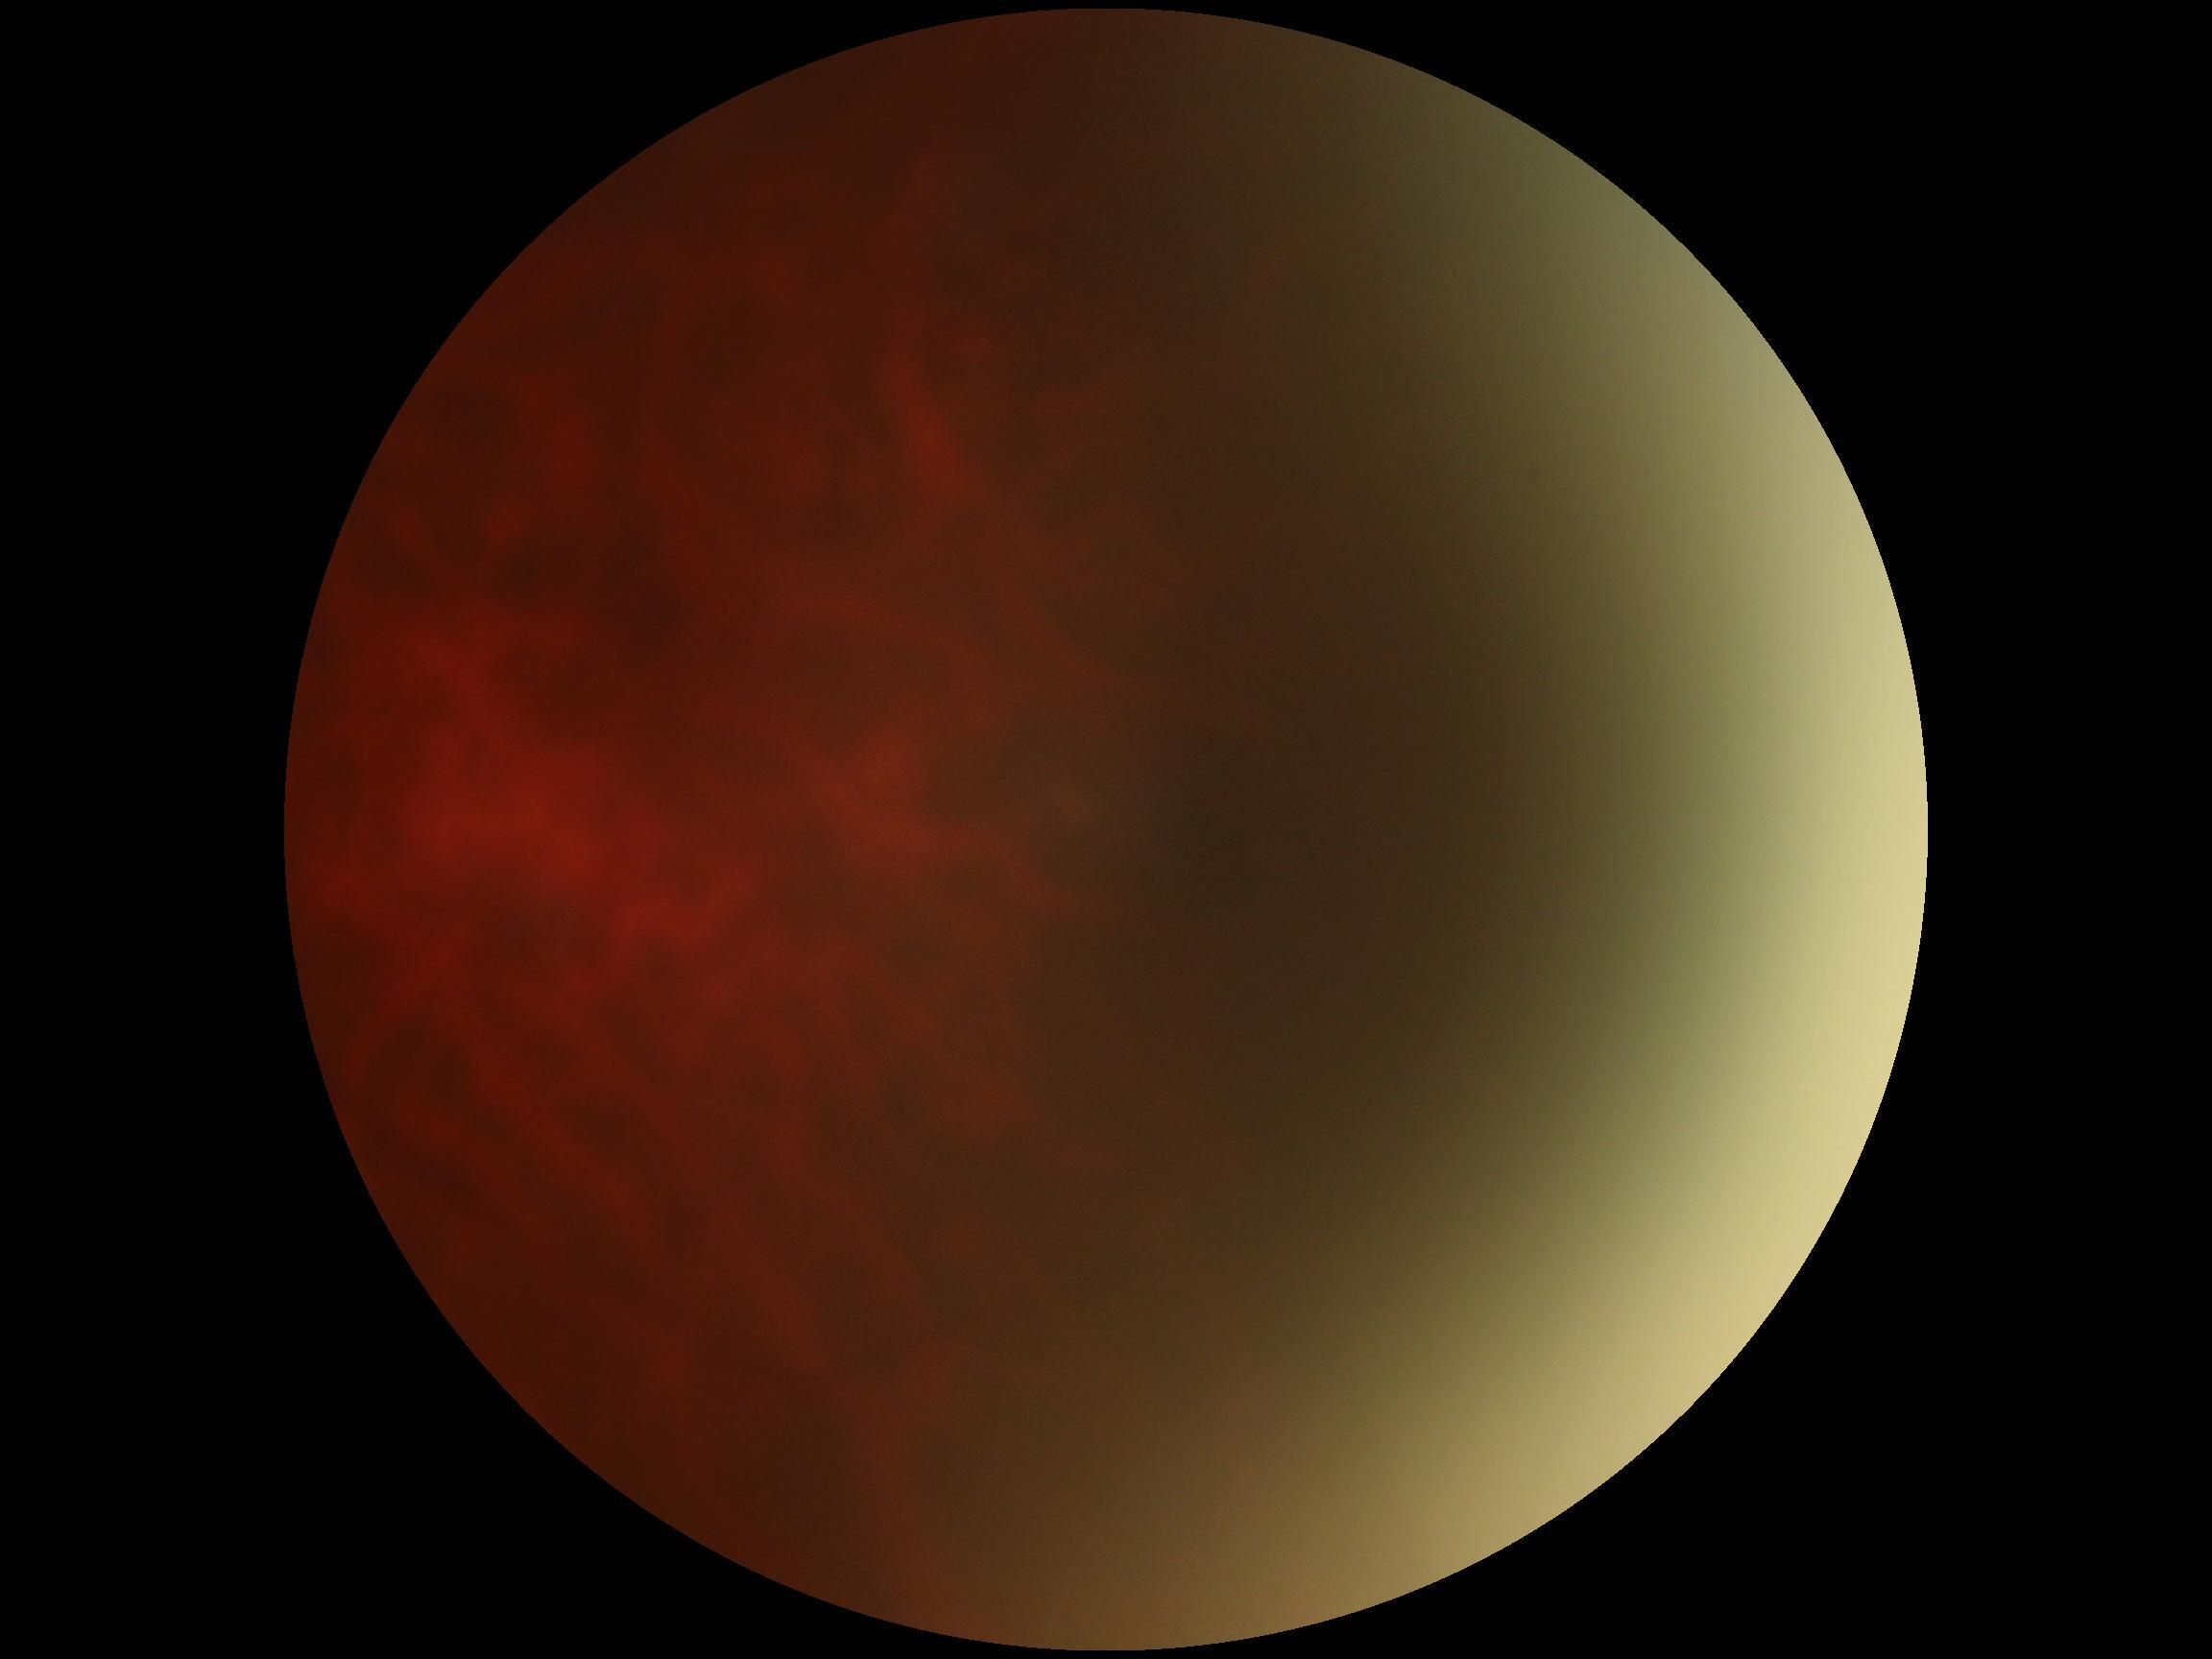 Retinopathy grade is ungradable.